Pediatric wide-field fundus photograph:
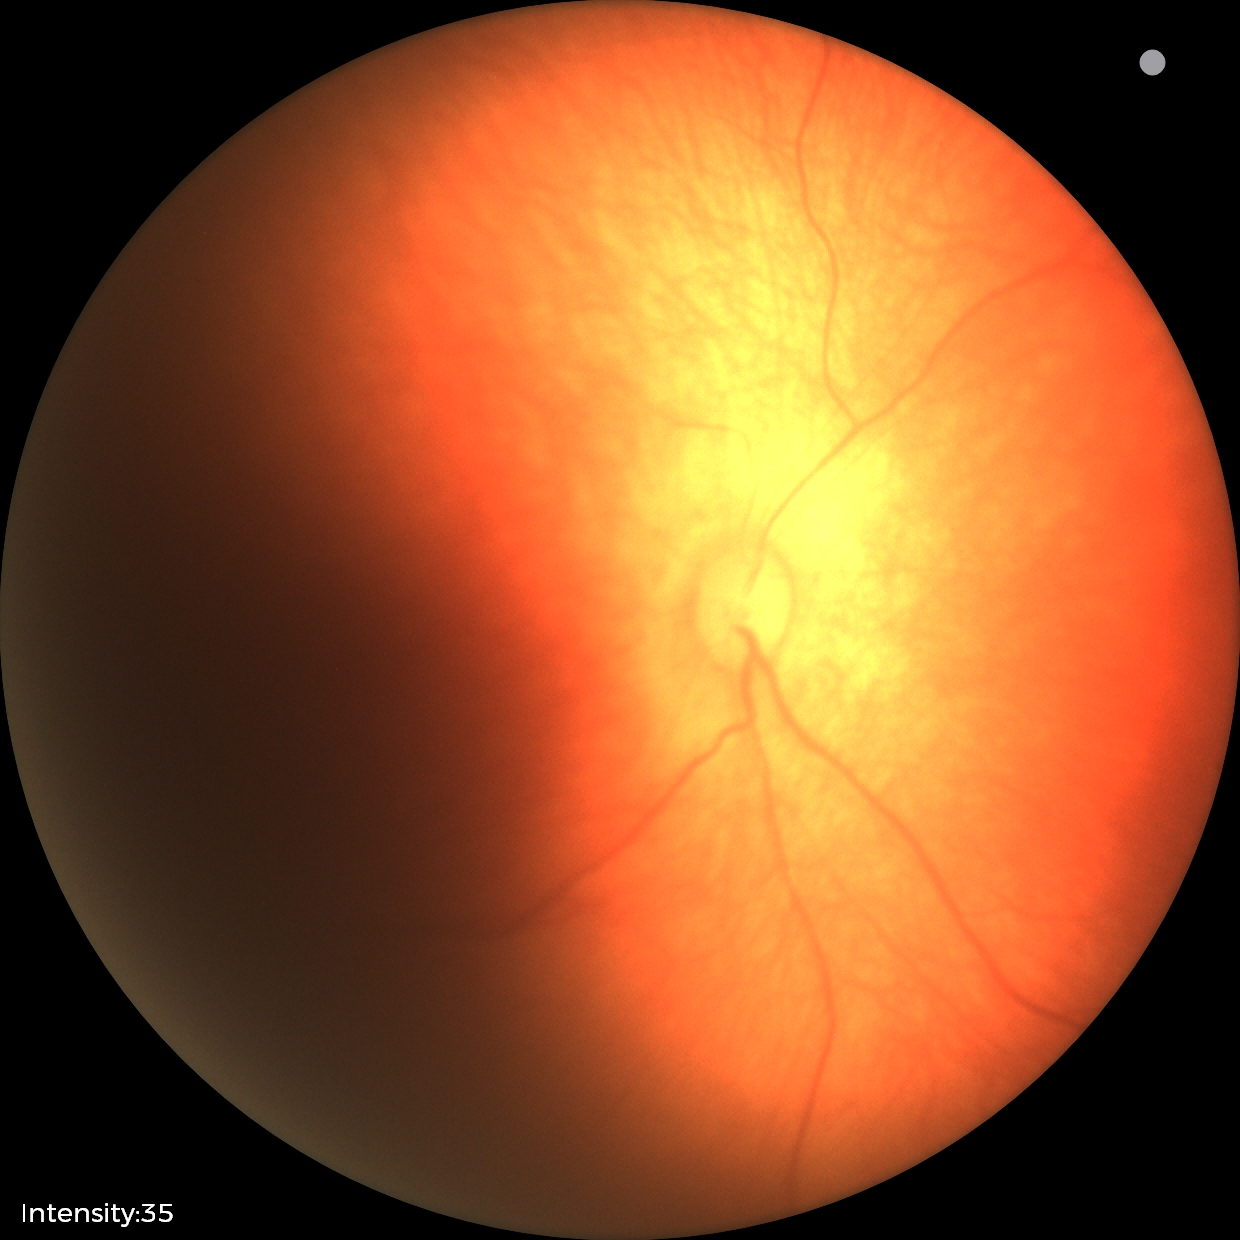 Physiological retinal appearance for postconceptual age.